45° FOV — 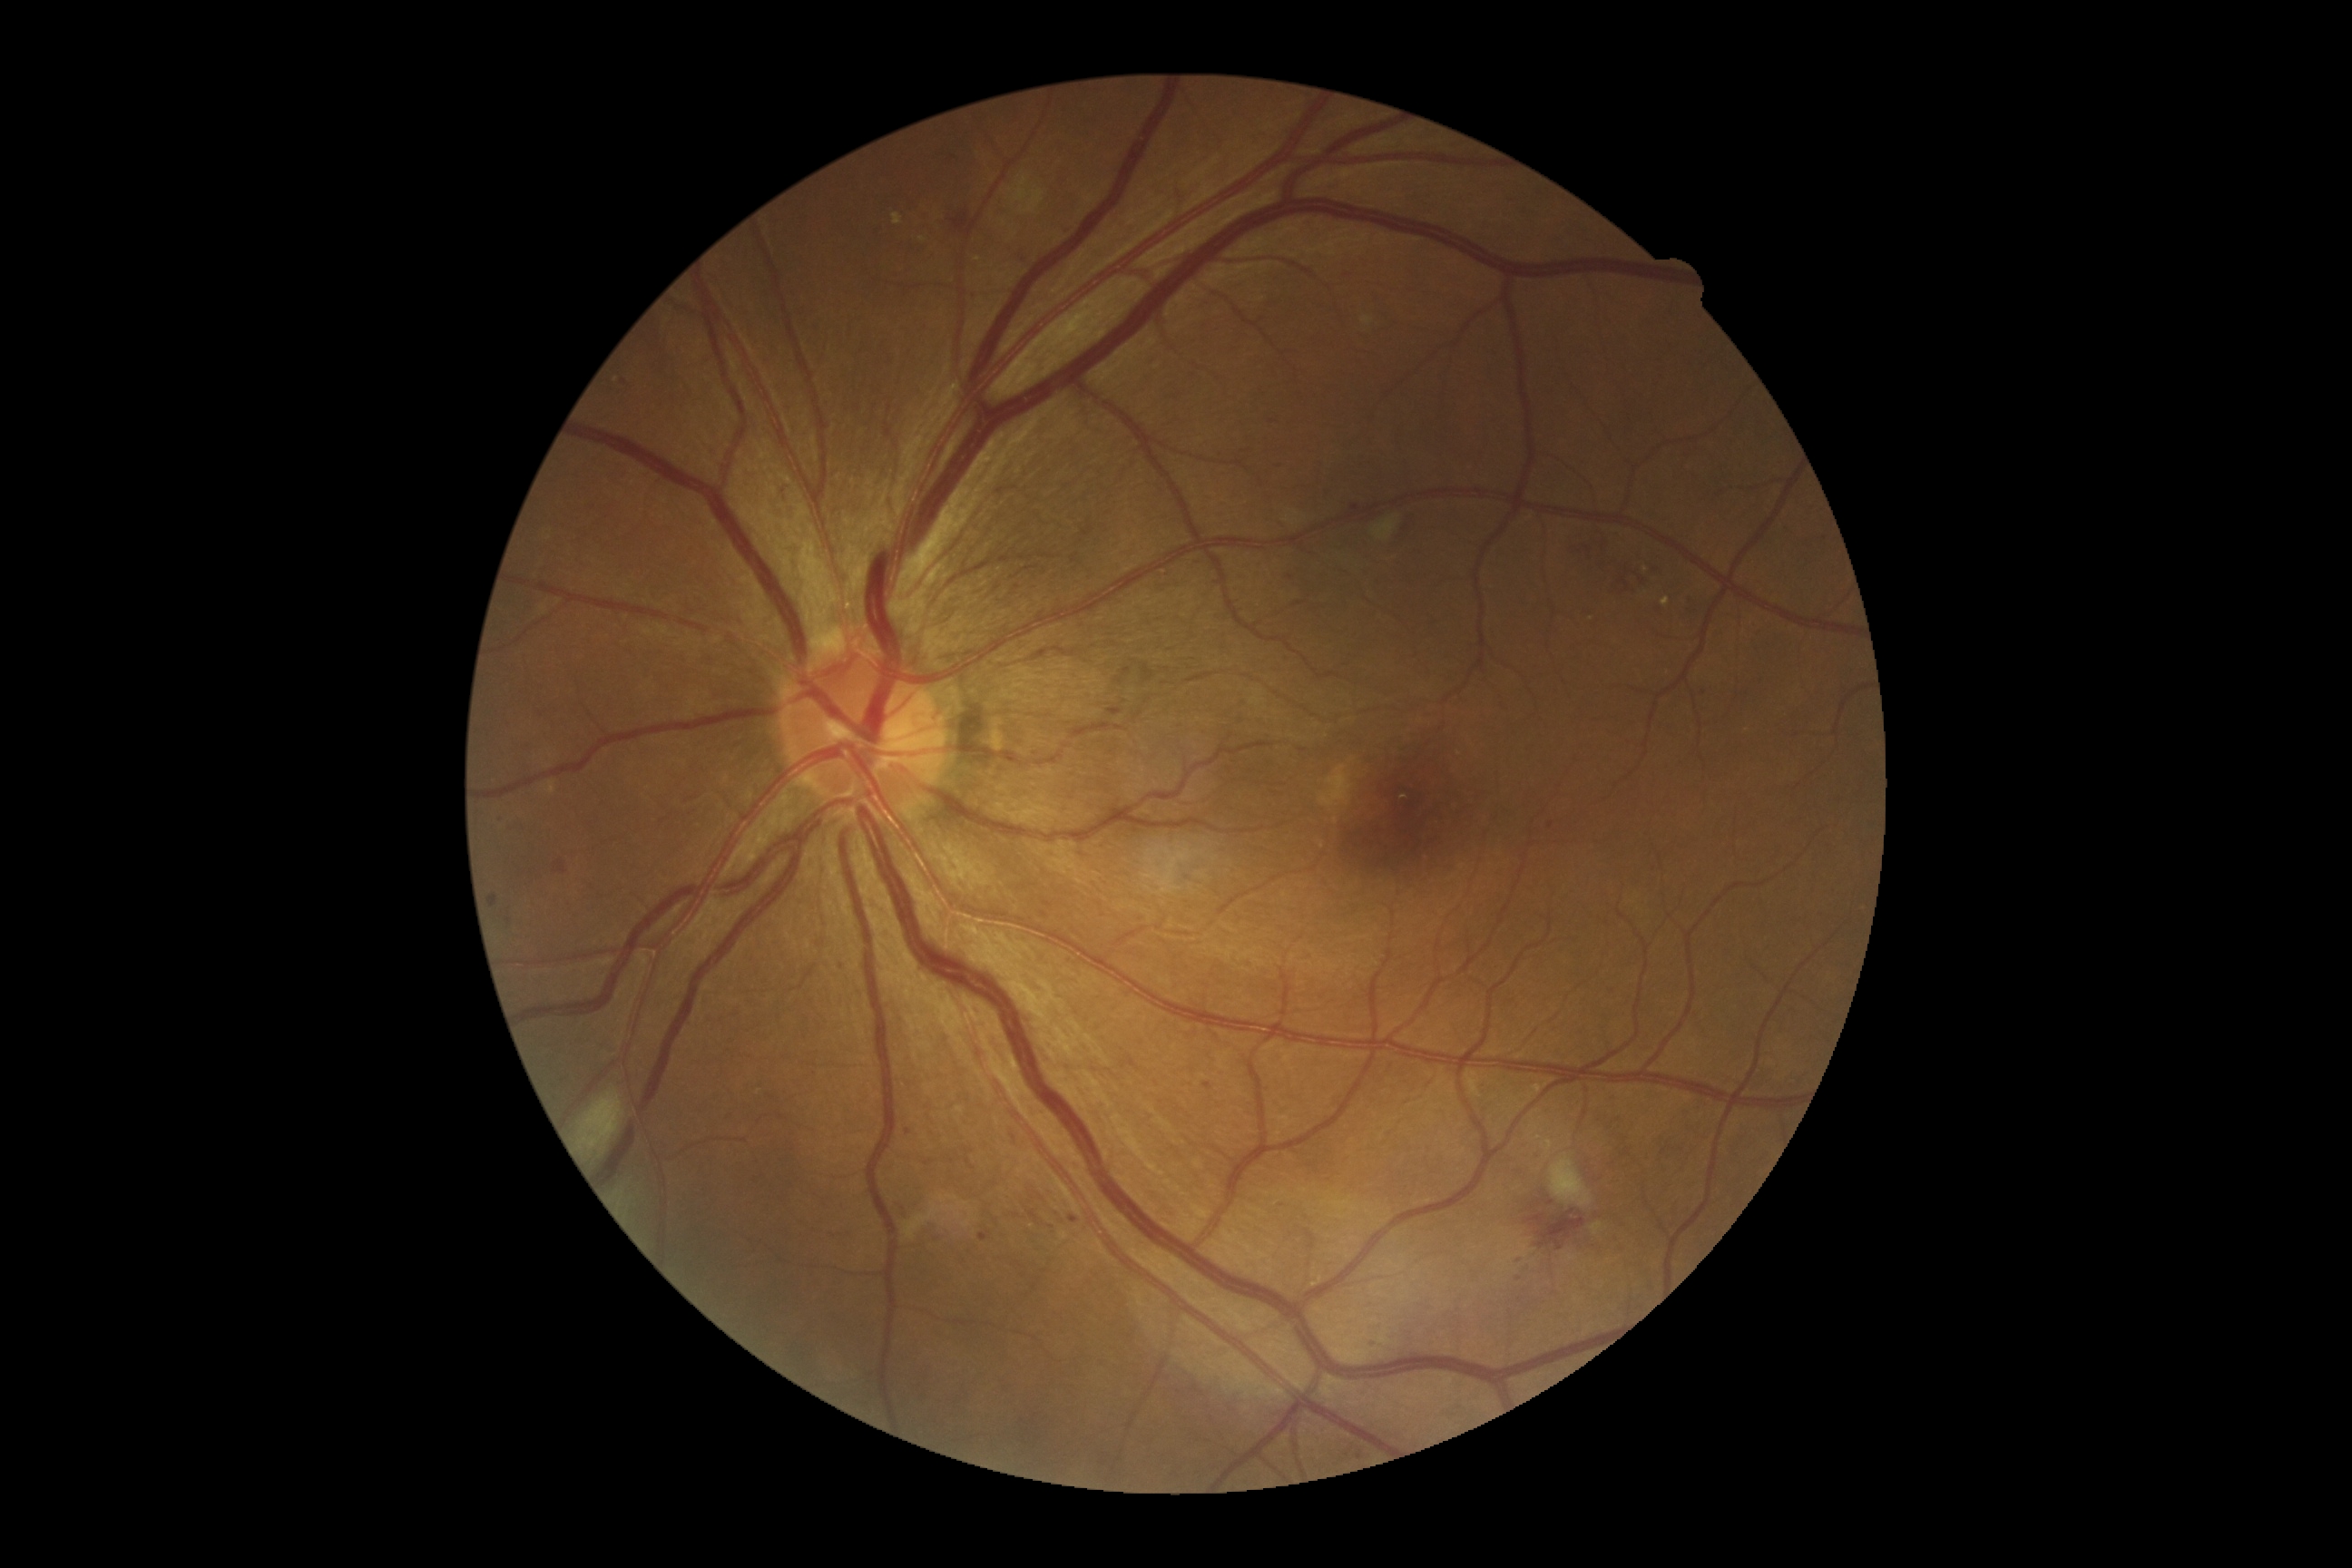
<lesions partial="true">
  <dr_grade>2</dr_grade>
  <ma partial="true">1369,1342,1380,1348 | 1534,1155,1542,1164 | 1070,1215,1079,1224 | 1351,505,1360,516 | 1204,1083,1213,1090 | 839,961,847,968 | 1787,525,1792,536 | 979,1233,990,1242</ma>
  <ma_small_centers>(1550; 1204) | (1705; 694) | (1282; 1206) | (908; 1132) | (1551; 826) | (1520; 1301) | (1278; 464) | (501; 818) | (1346; 1455) | (1825; 539) | (1290; 578)</ma_small_centers>
  <ex partial="true">892,213,903,226 | 1661,598,1671,607</ex>
  <ex_small_centers>(1460; 754) | (616; 380) | (922; 240) | (1646; 570) | (978; 259)</ex_small_centers>
  <se>1008,173,1046,215 | 1591,1222,1603,1237 | 1362,317,1375,328 | 903,1195,977,1240 | 1549,1155,1592,1208 | 580,1092,625,1152 | 1371,516,1398,542</se>
  <he>1612,560,1660,600 | 1108,709,1122,716 | 491,894,498,908 | 1574,538,1596,554 | 948,210,968,233 | 1028,1211,1039,1224 | 553,861,569,876 | 1142,665,1153,683 | 897,1199,910,1220 | 1525,1210,1587,1251 | 1122,667,1132,676</he>
</lesions>